Captured on a Nidek AFC-330 fundus camera — 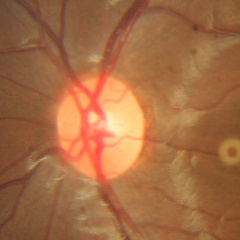

Optic nerve head appearance consistent with no glaucomatous optic neuropathy.